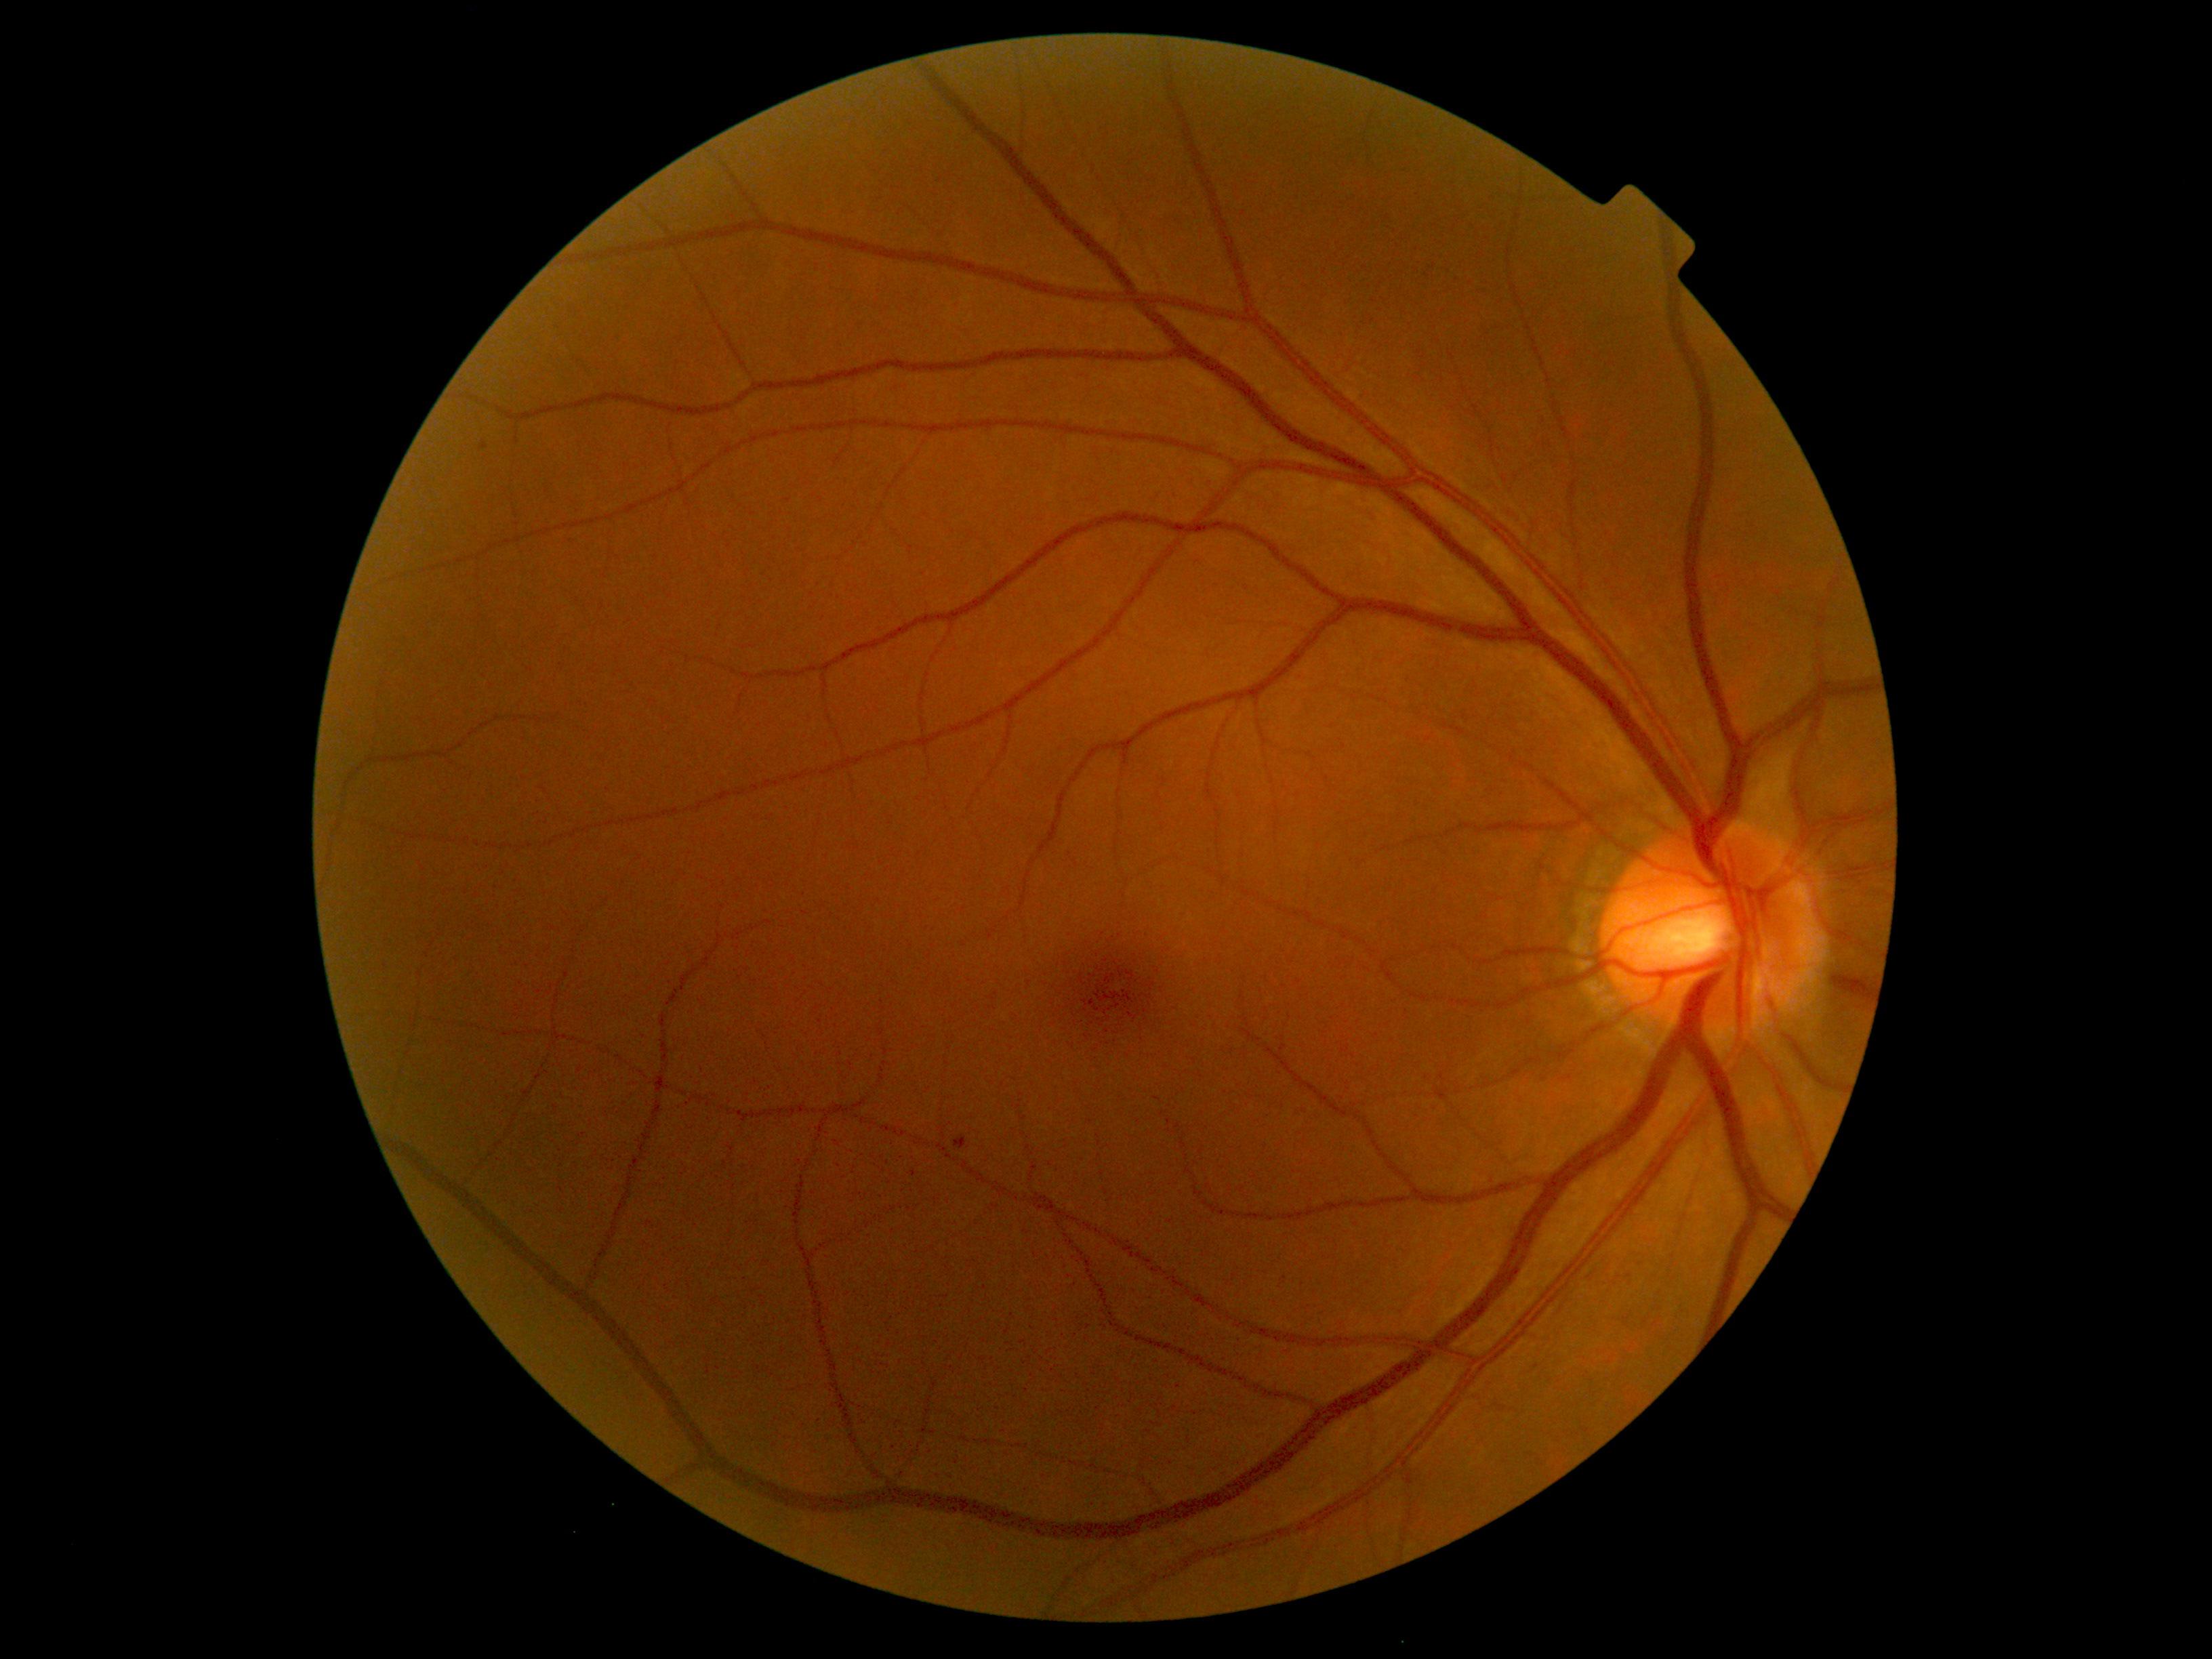

Diabetic retinopathy (DR): 1/4 — presence of microaneurysms only
microaneurysms (MAs): {"left": 954, "top": 1135, "right": 967, "bottom": 1150} | {"left": 482, "top": 443, "right": 487, "bottom": 452}
soft exudates (SEs): none identified
hemorrhages (HEs): none identified
hard exudates (EXs): none identified